DR severity per modified Davis staging.
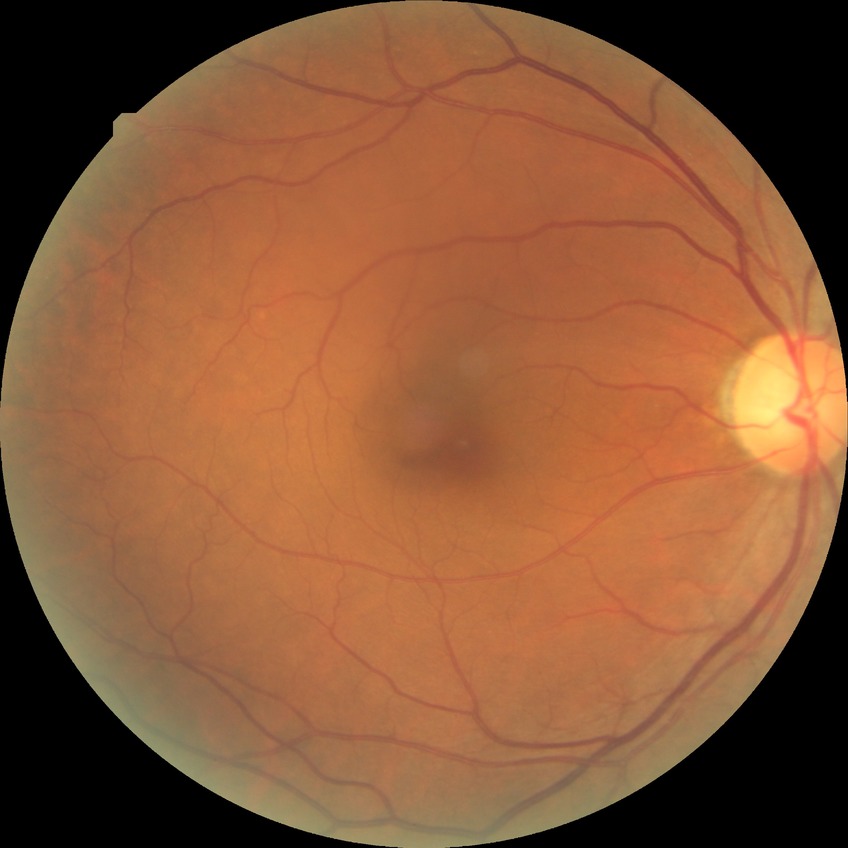 Diabetic retinopathy (DR) is no diabetic retinopathy (NDR).